DR severity per modified Davis staging, 45 degree fundus photograph — 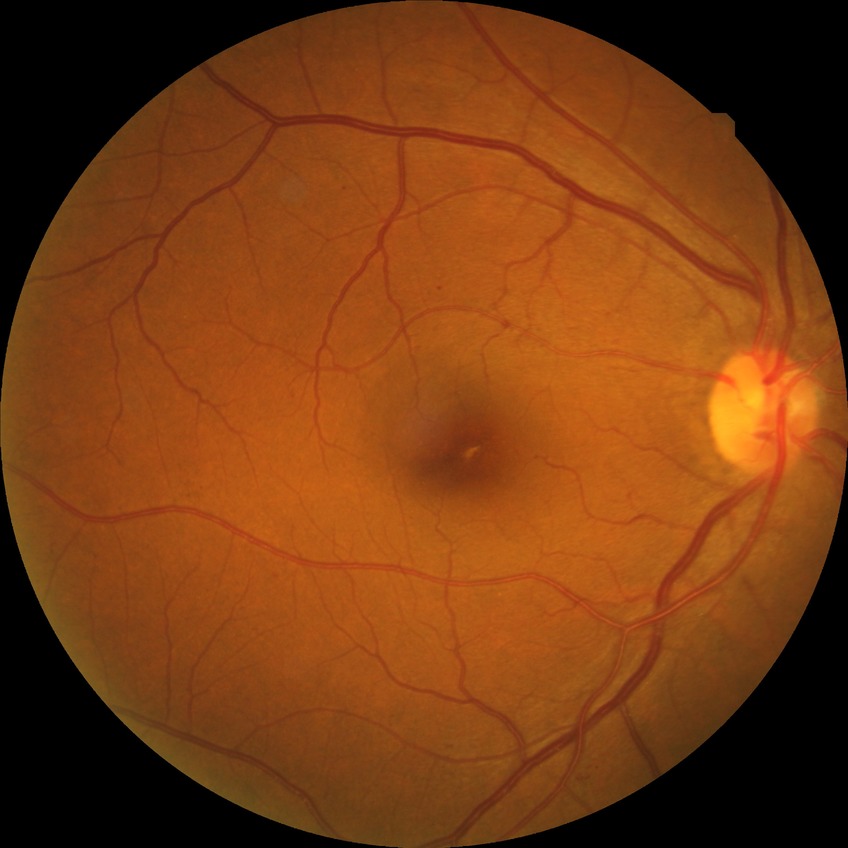

diabetic retinopathy grade: simple diabetic retinopathy.